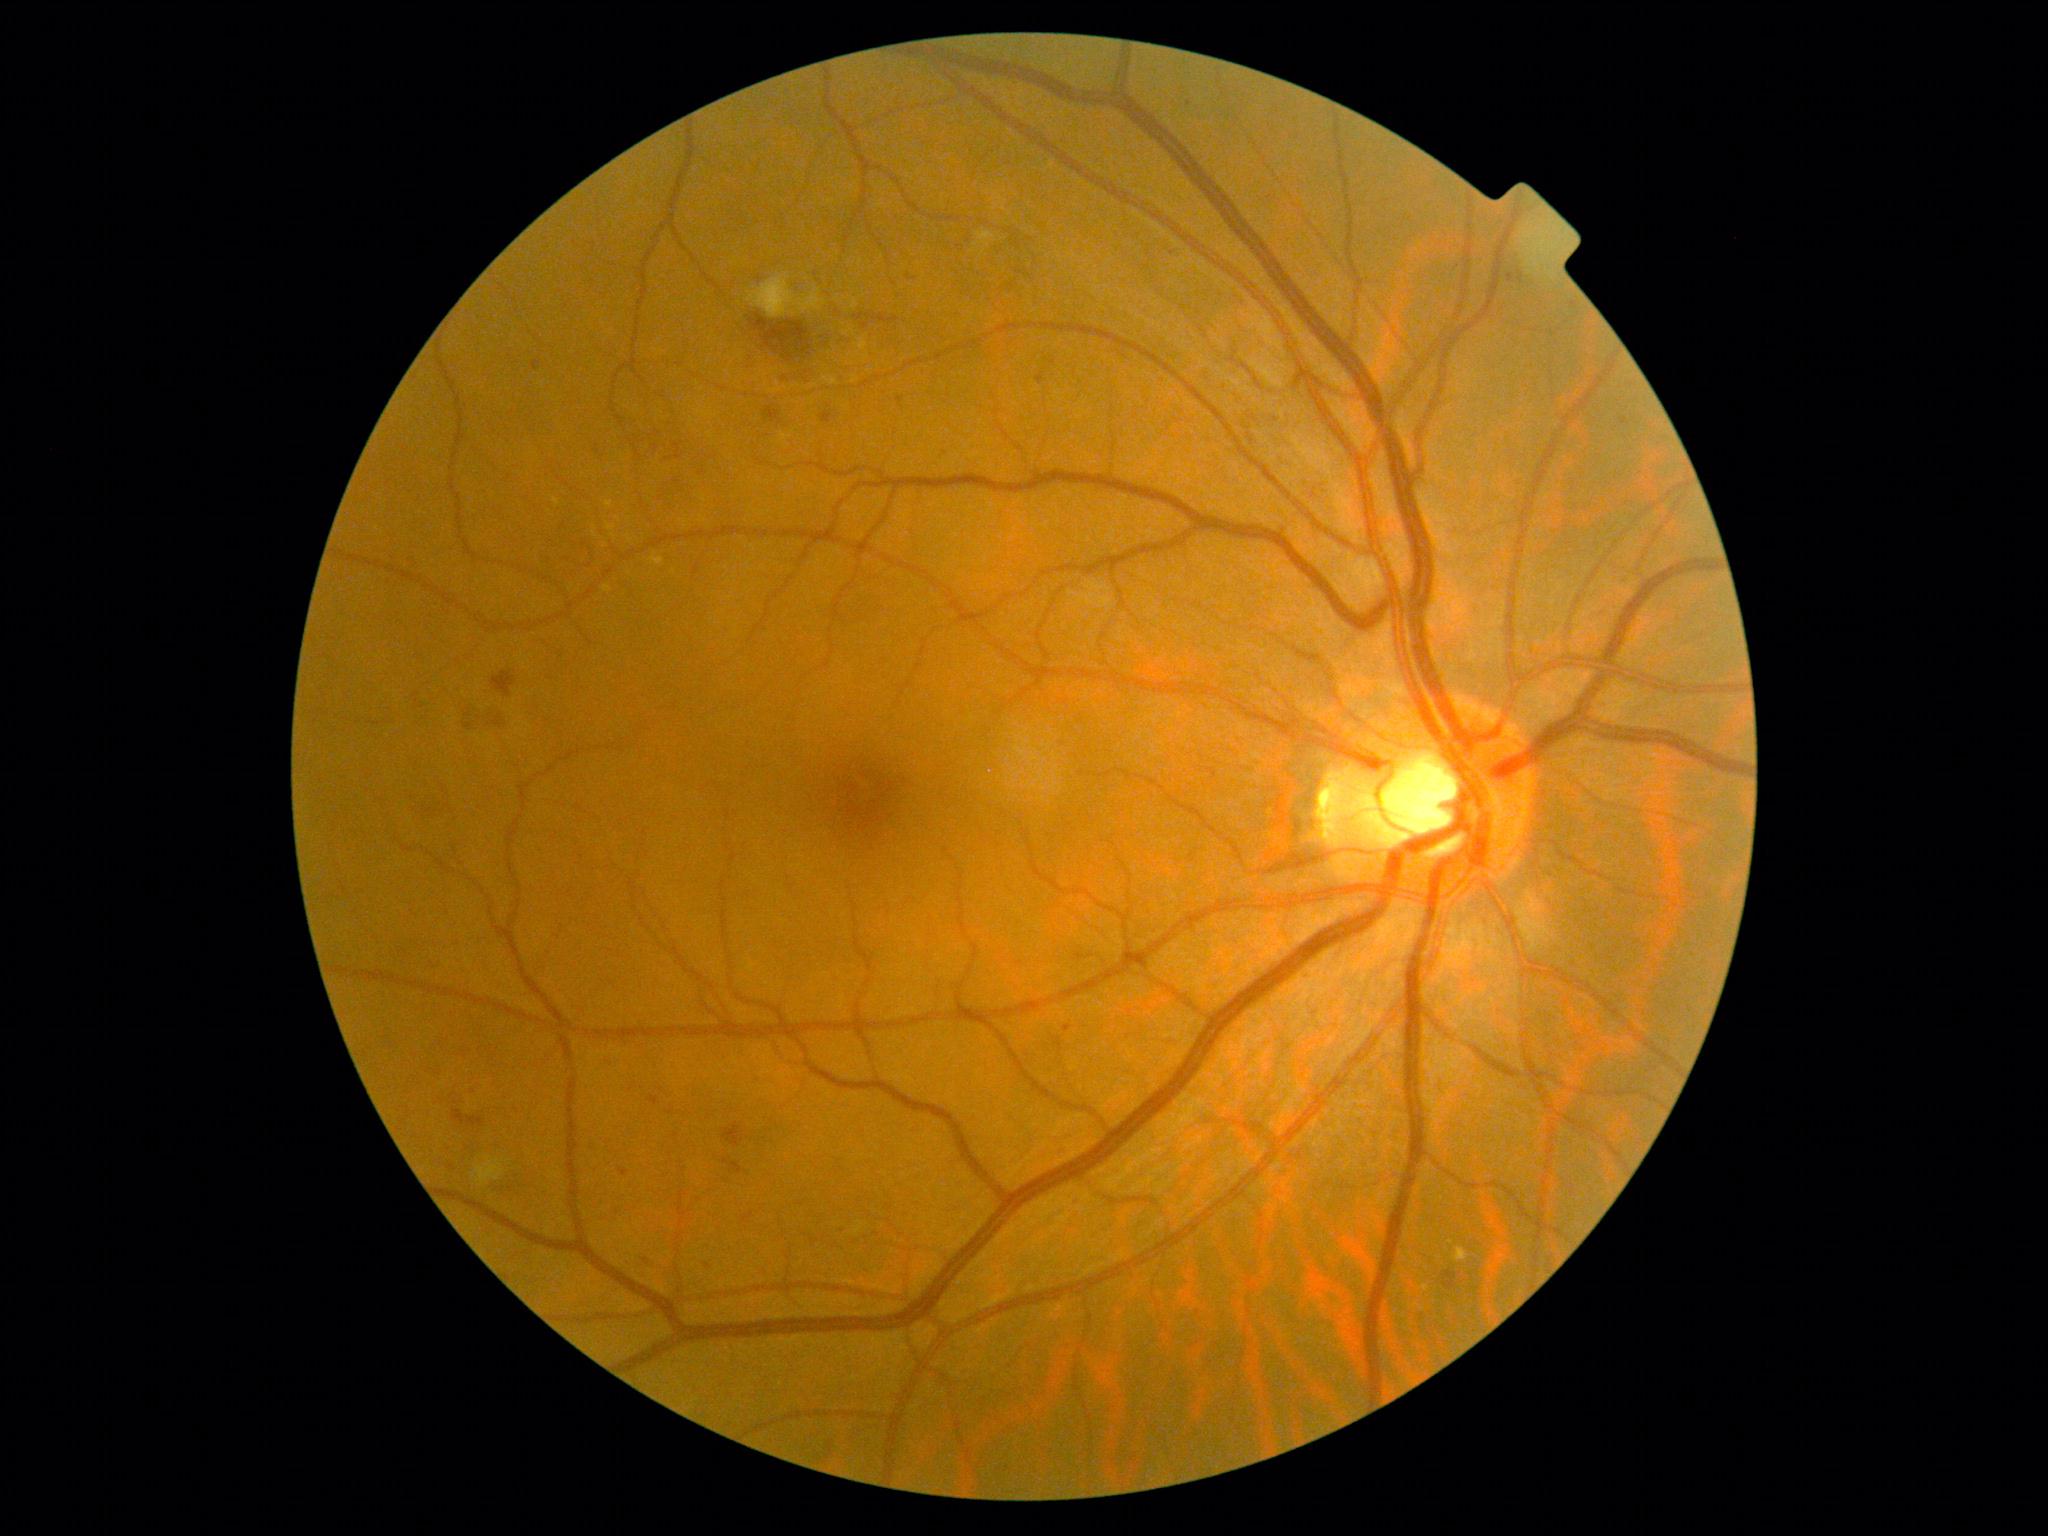 diabetic retinopathy (DR)=grade 2 (moderate NPDR).